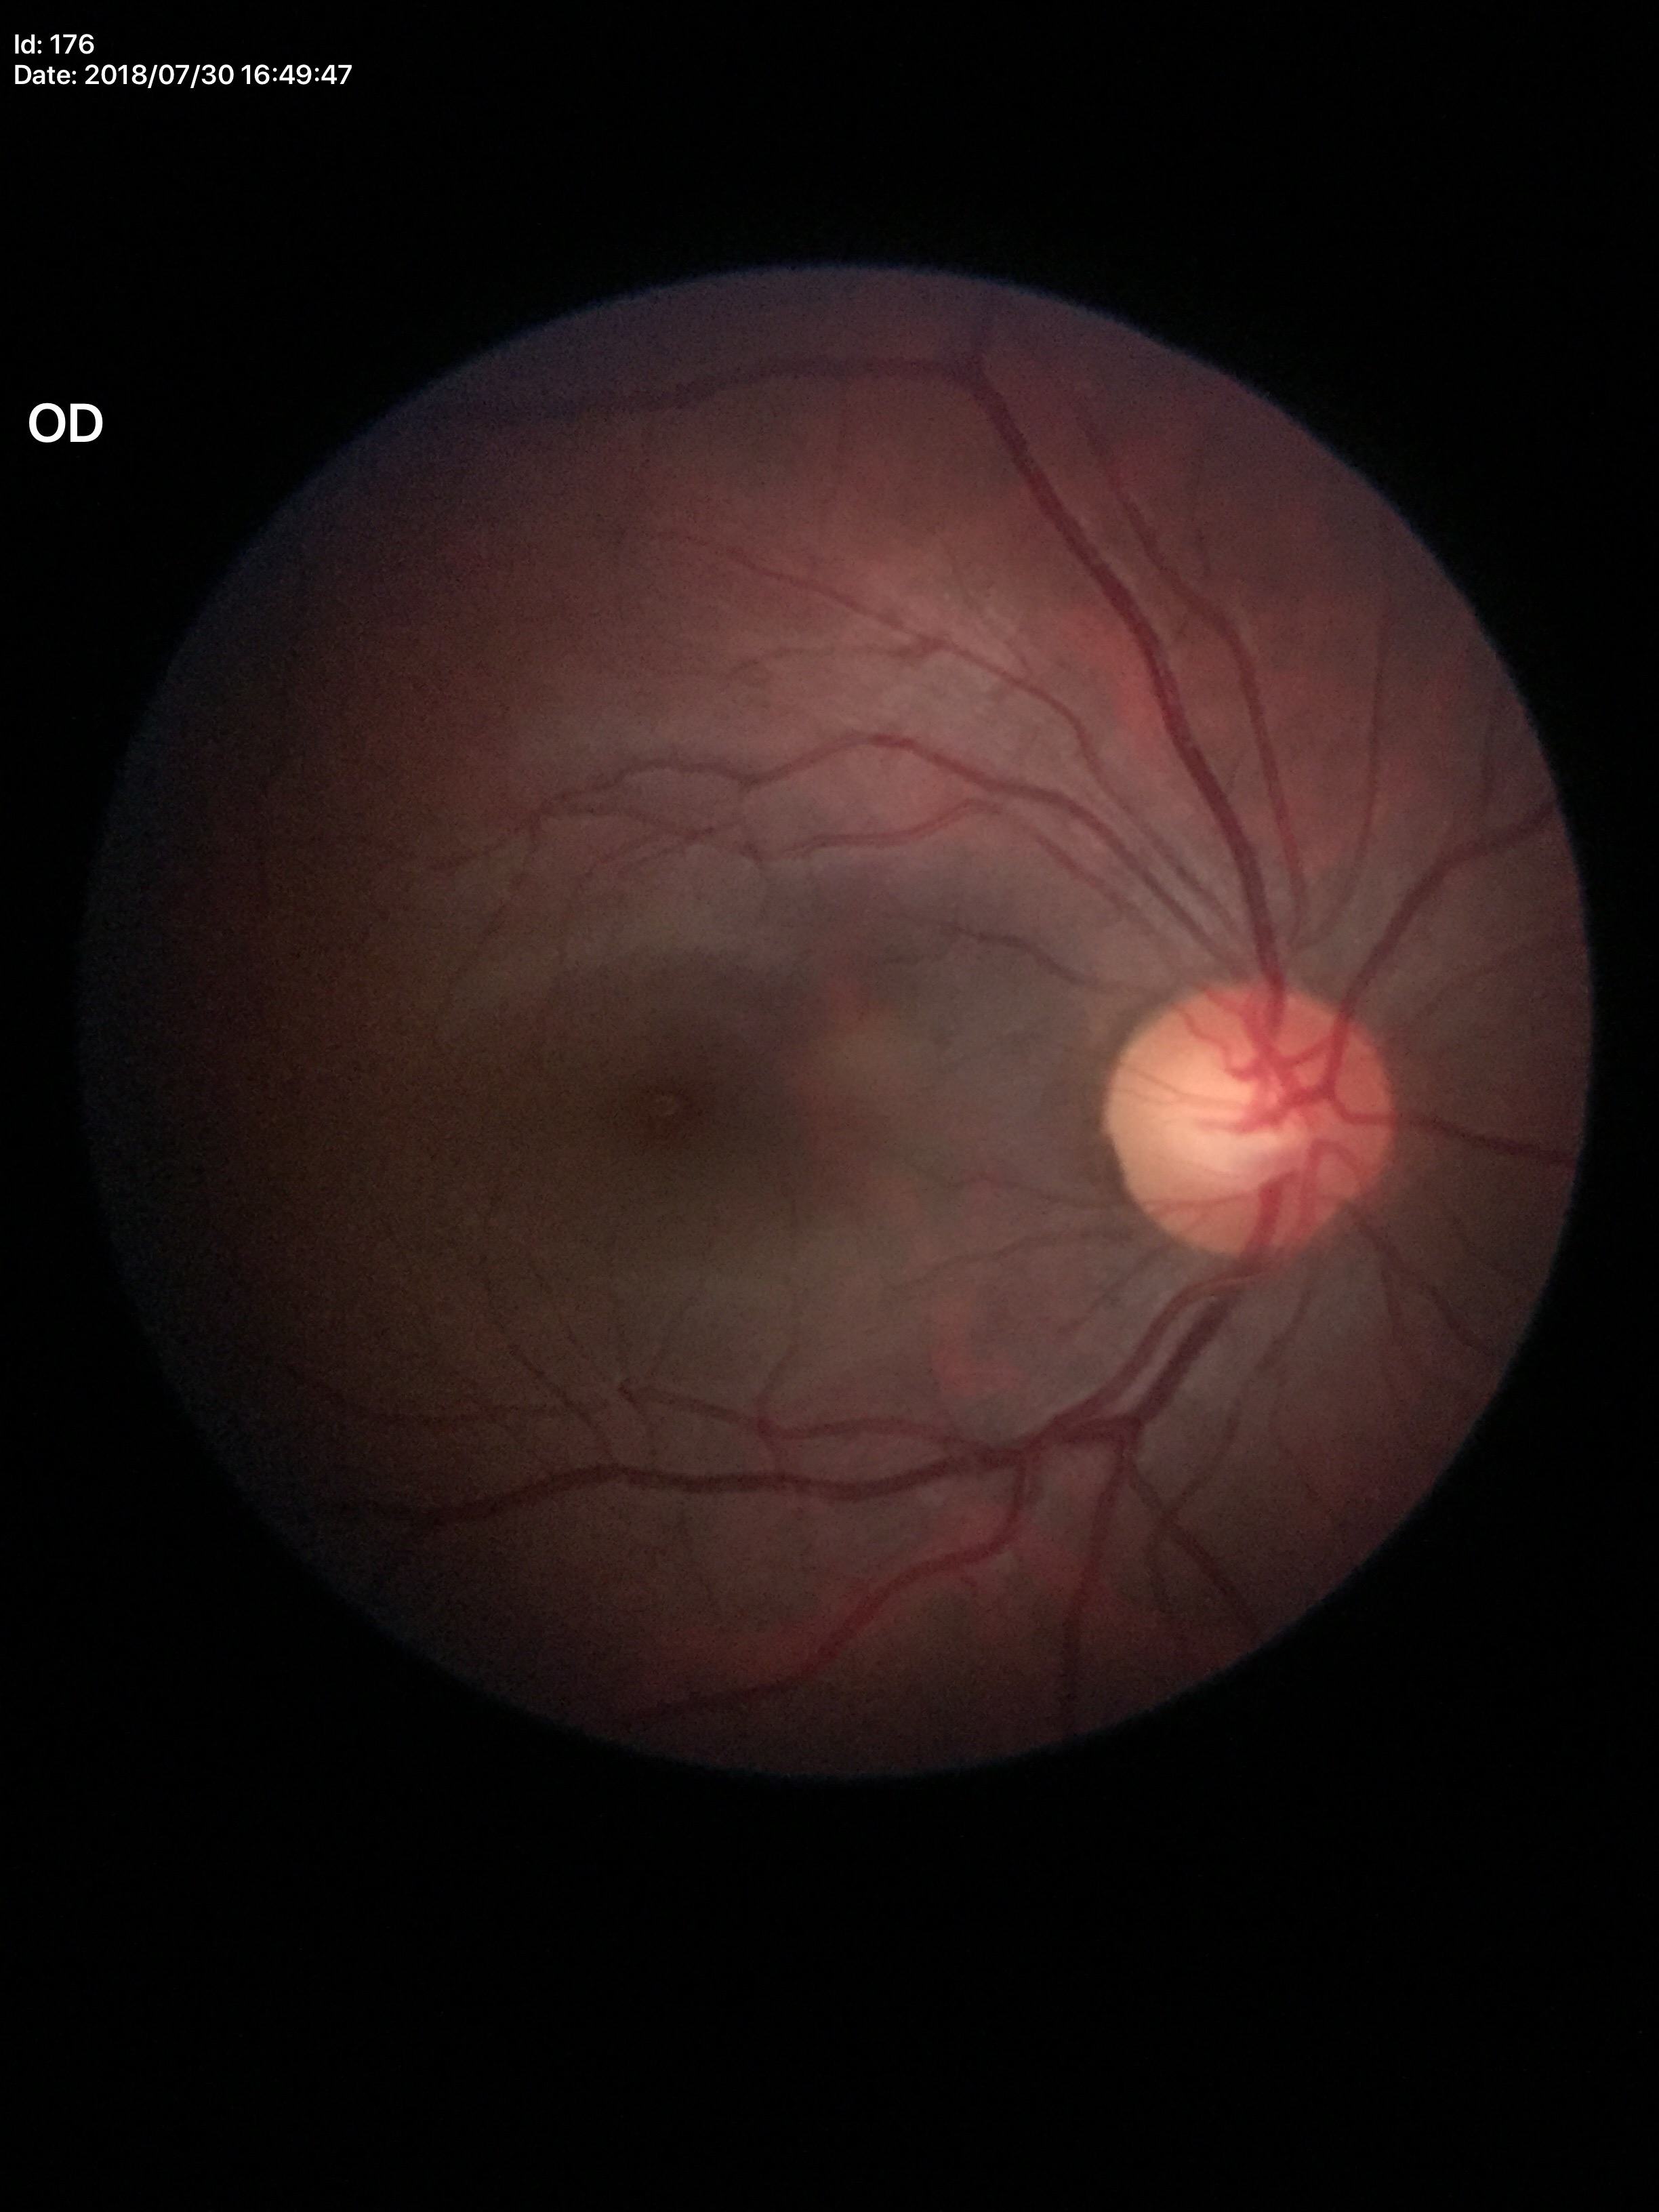 Glaucoma screening: not suspect | area cup-disc ratio: 0.29 | vertical CDR: 0.56